CFP:
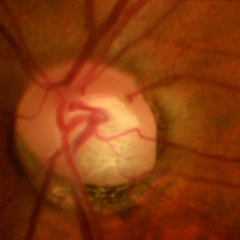

Q: Is glaucoma present?
A: Yes — early glaucoma.